2352x1568px · CFP · 45-degree field of view.
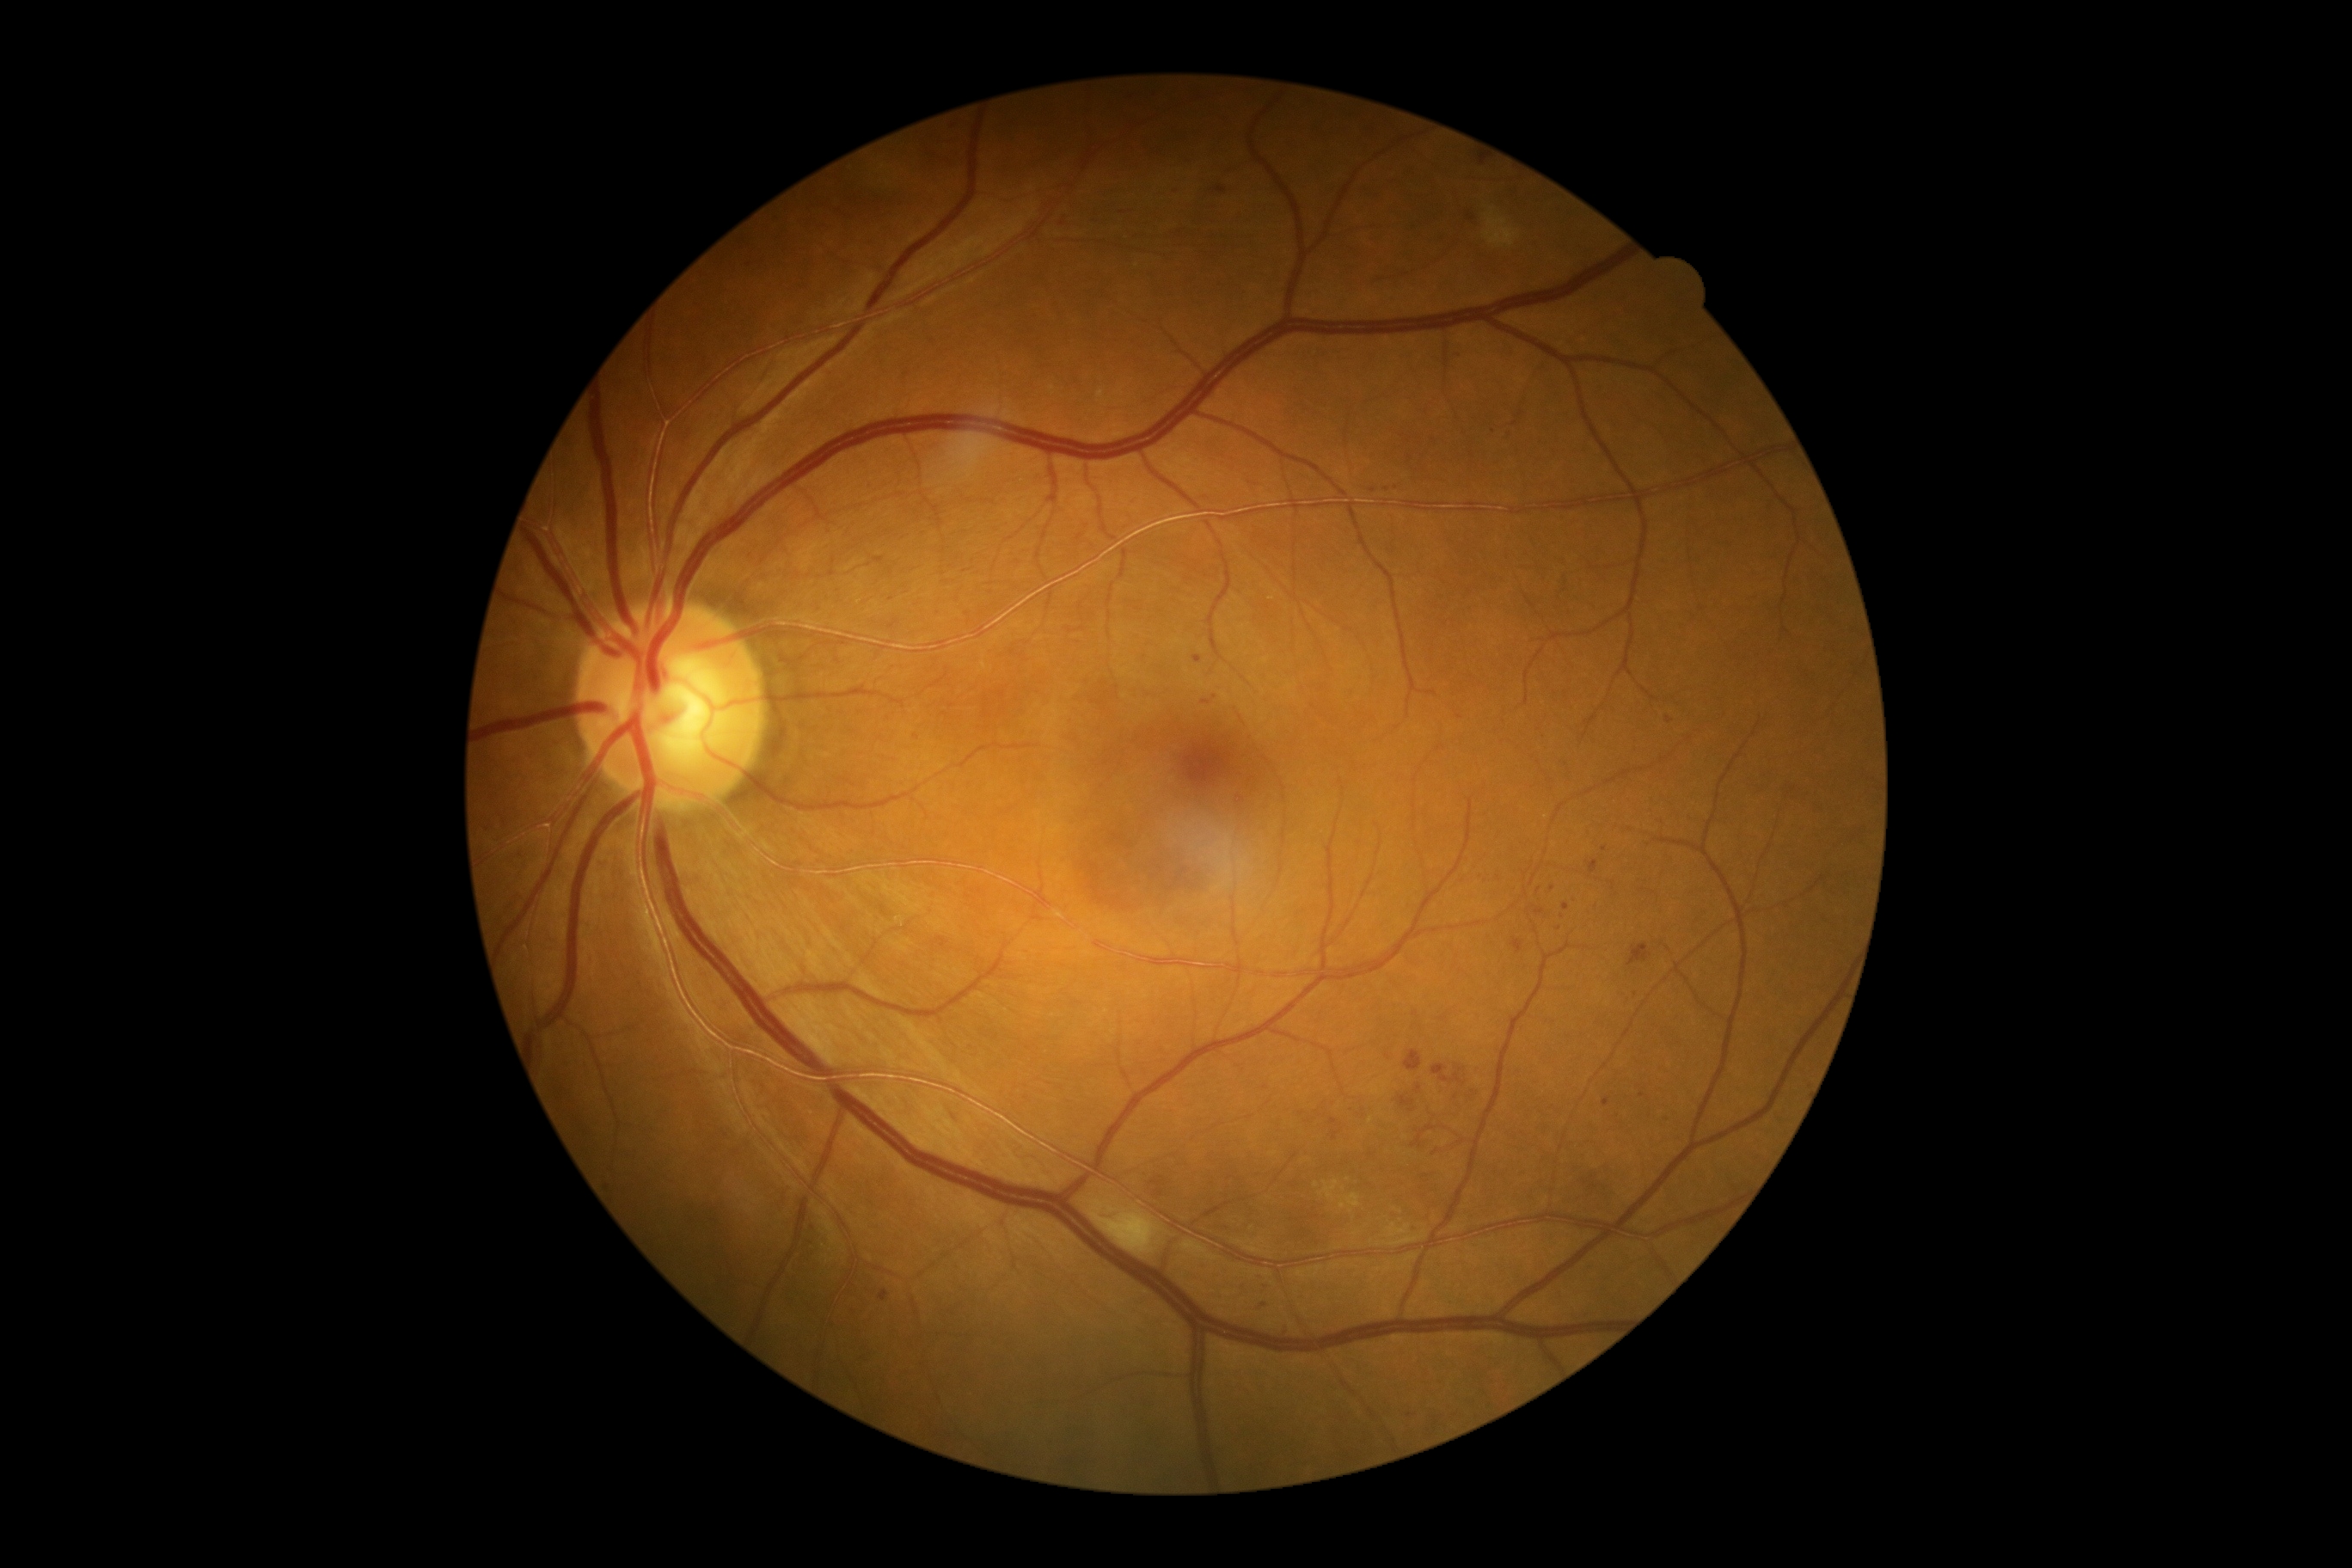
Diabetic retinopathy (DR): grade 2.